Wide-field fundus photograph of an infant; Clarity RetCam 3, 130° FOV
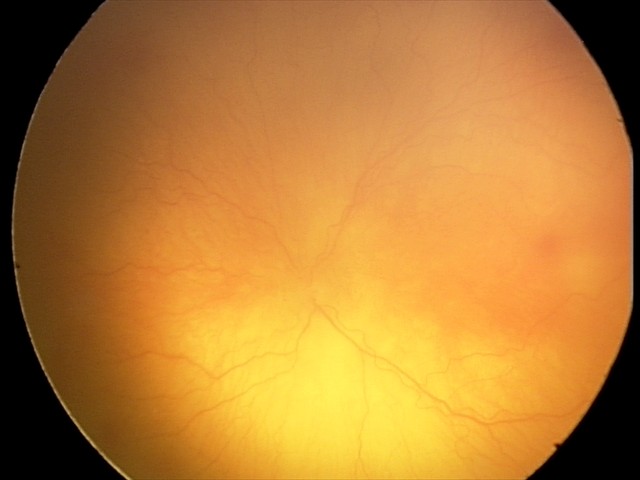

From an examination with diagnosis of aggressive retinopathy of prematurity (A-ROP).